1932x1932 — 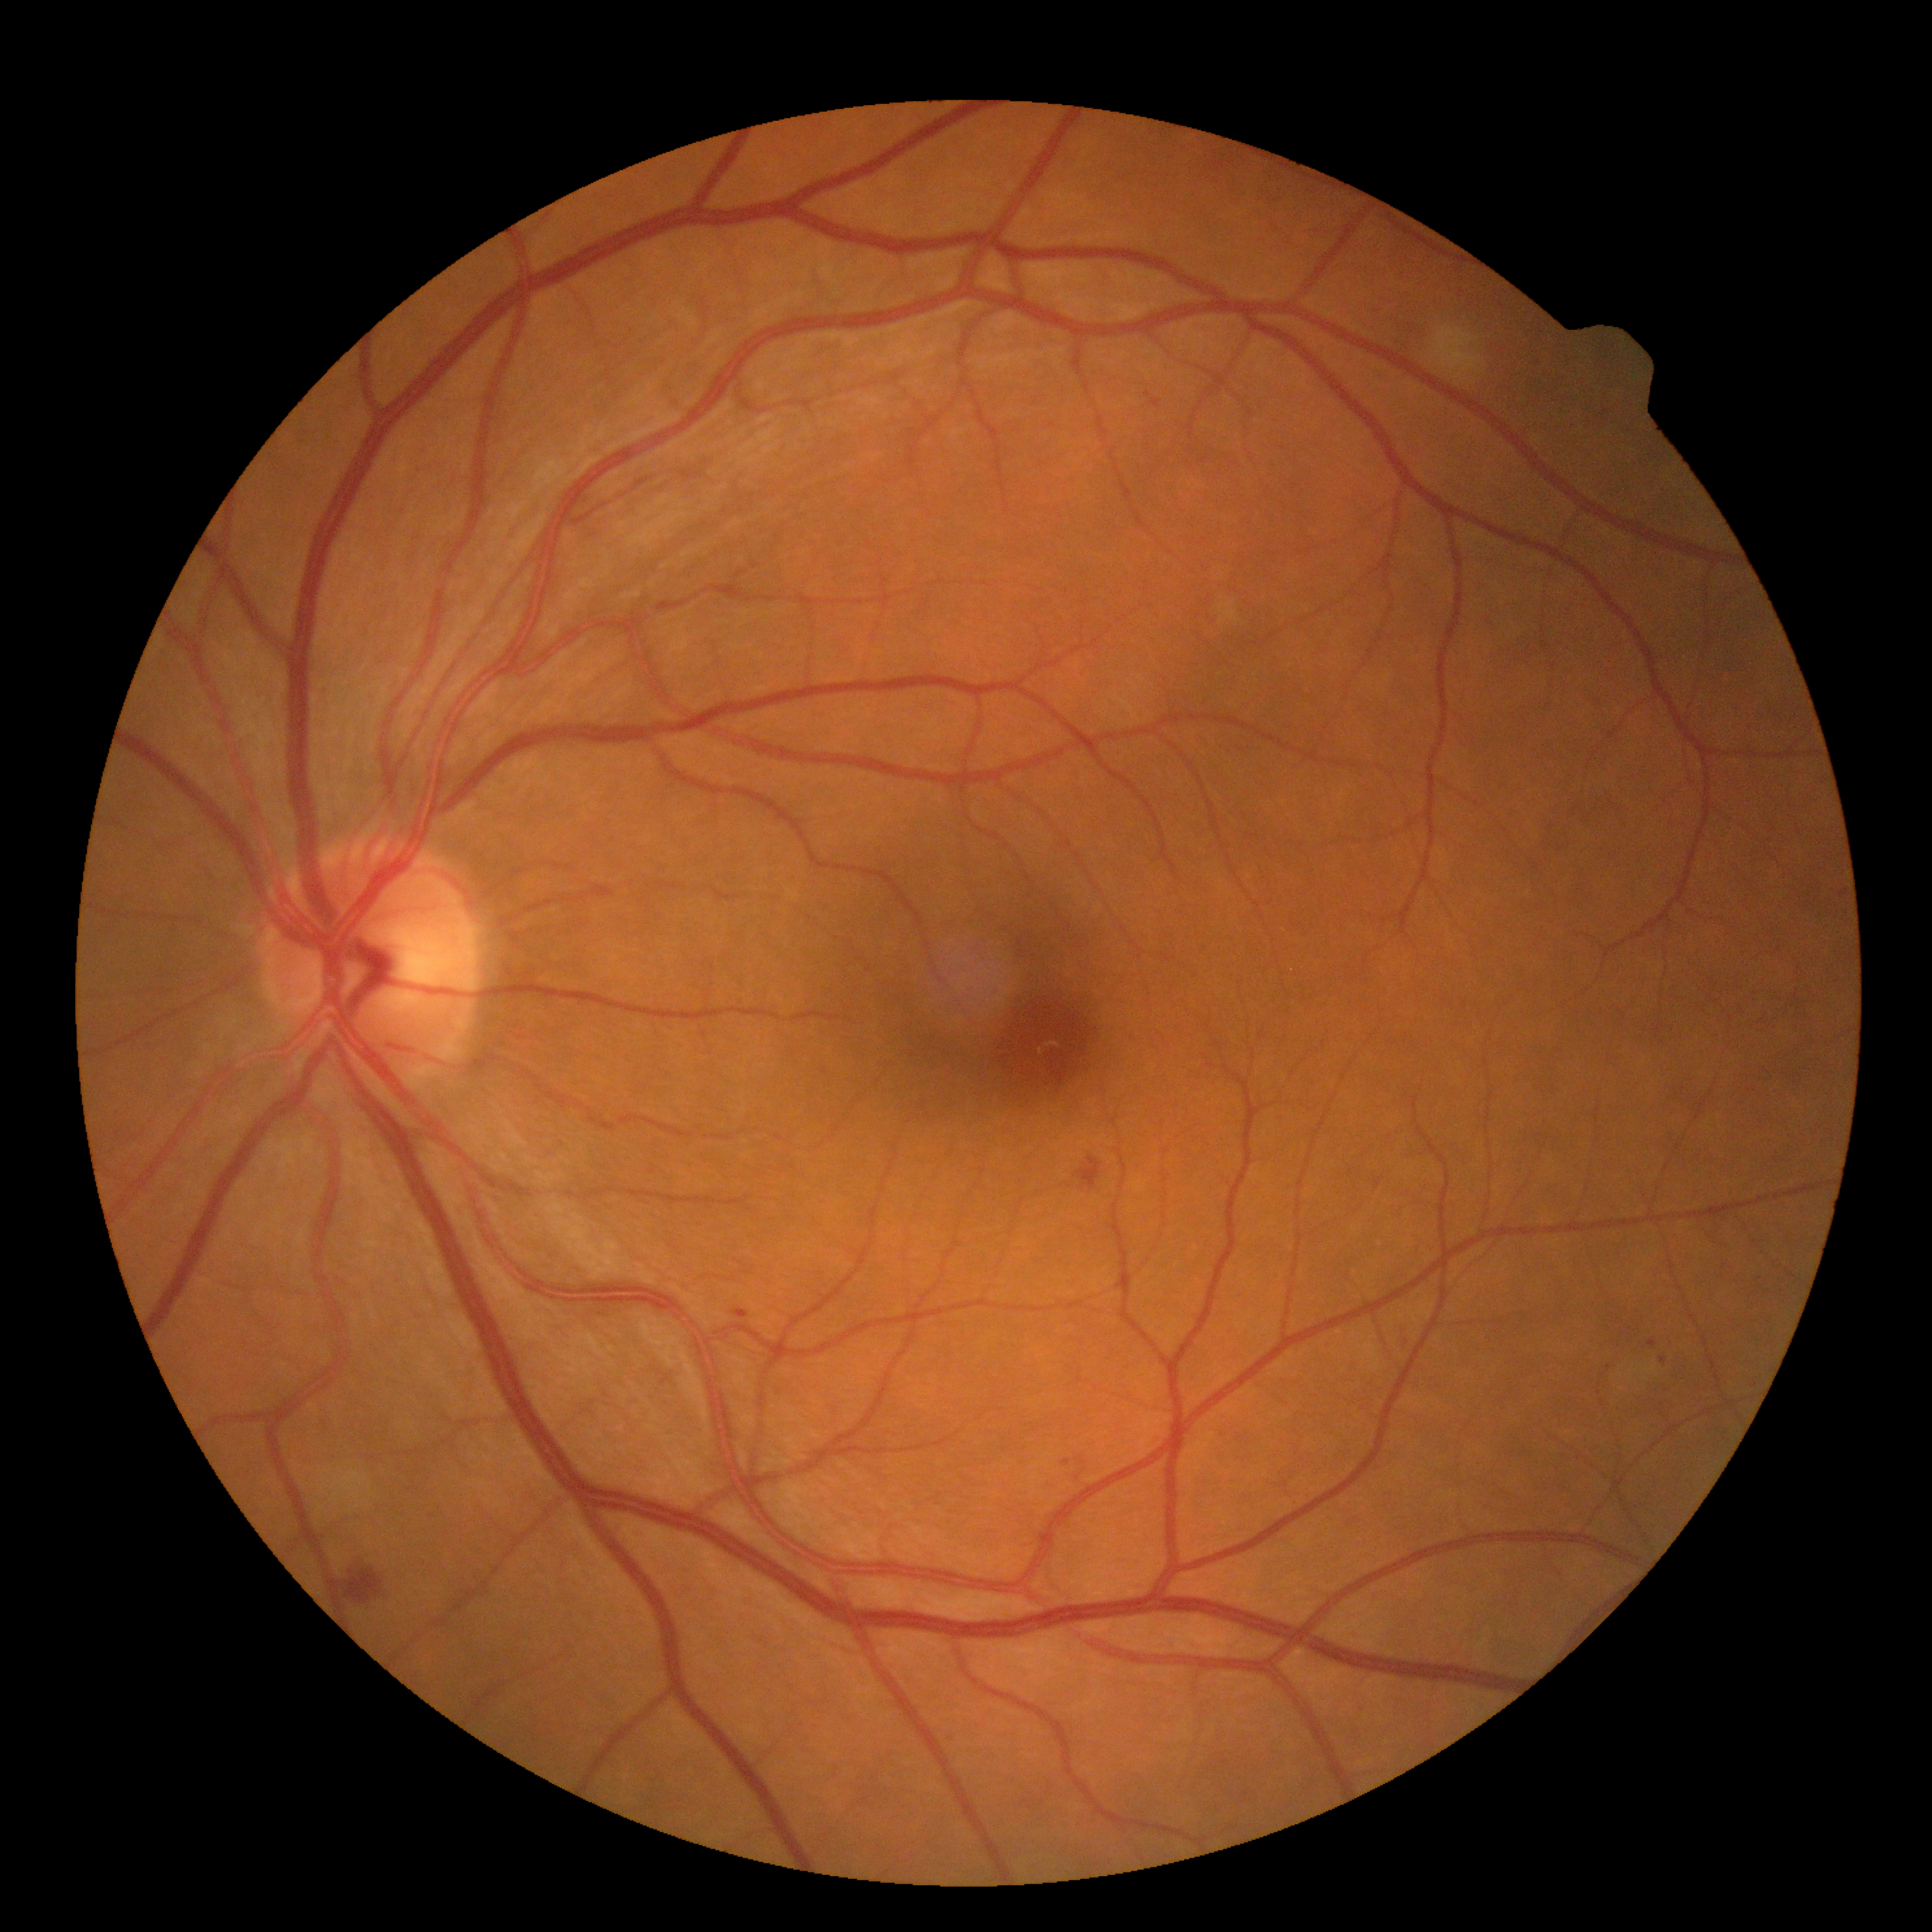
retinopathy grade@2; DR class@non-proliferative diabetic retinopathy.